Wide-field contact fundus photograph of an infant; Phoenix ICON, 100° FOV; 1240 x 1240 pixels: 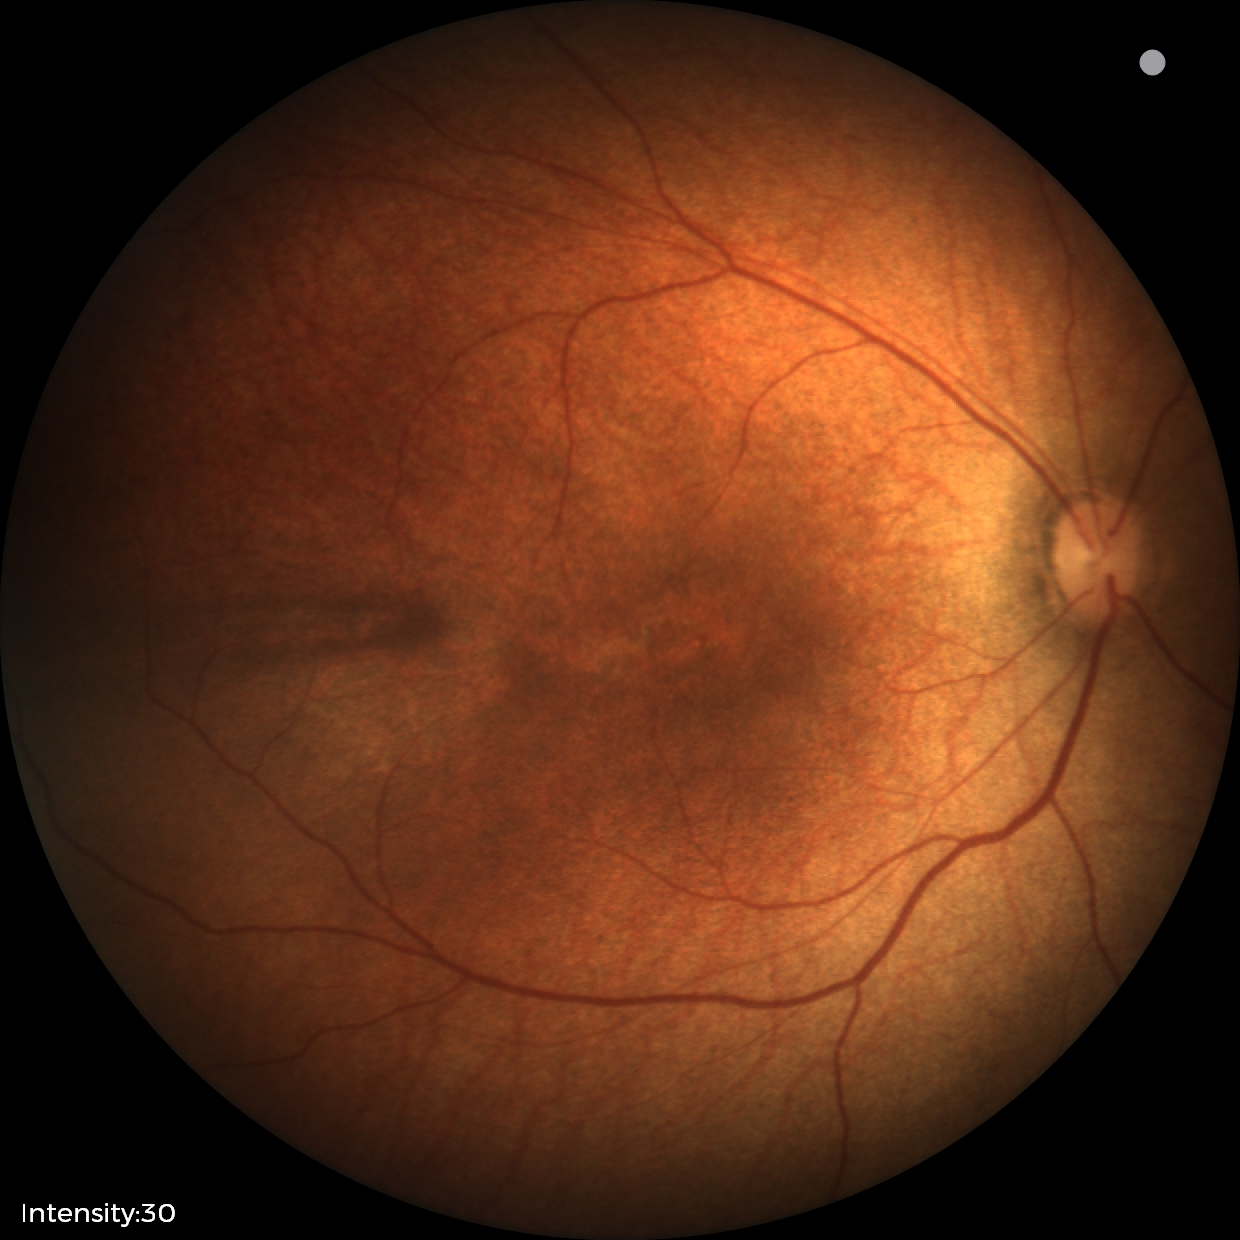

Normal screening examination.